Posterior pole color fundus photograph; camera: NIDEK AFC-230.
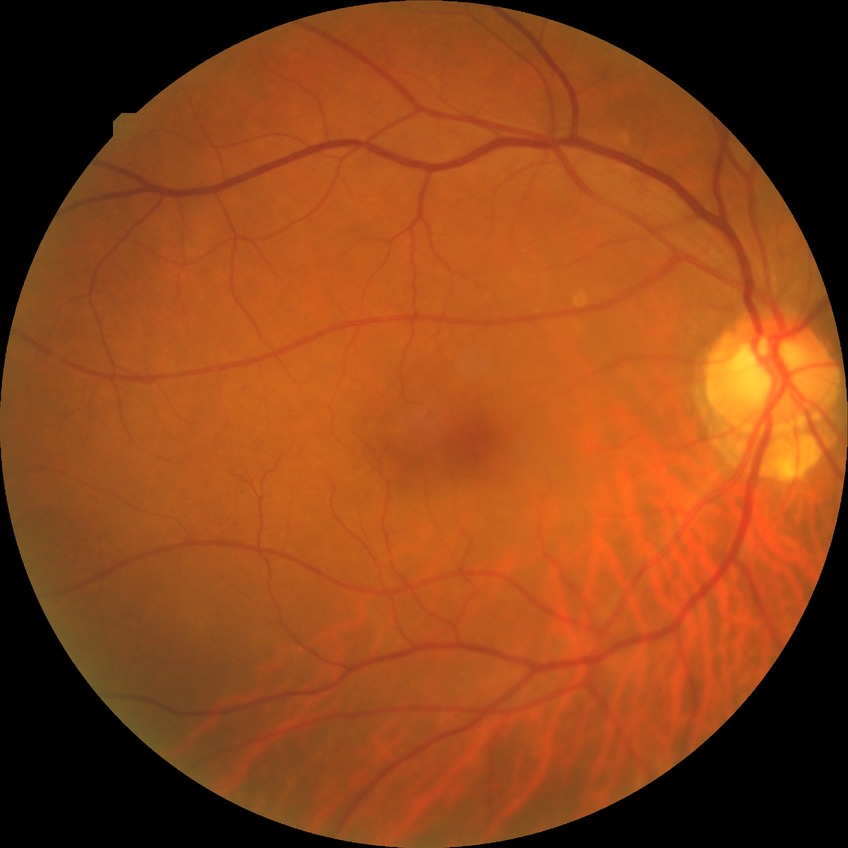
DR is NDR.